848 x 848 pixels, modified Davis grading — 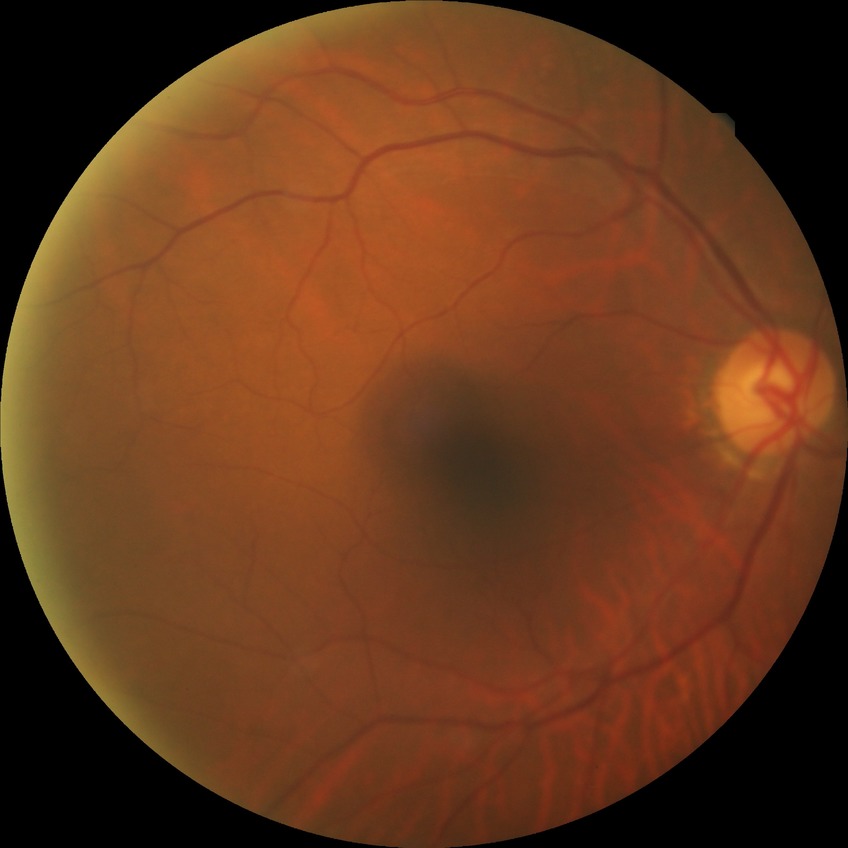

• retinopathy stage: no diabetic retinopathy